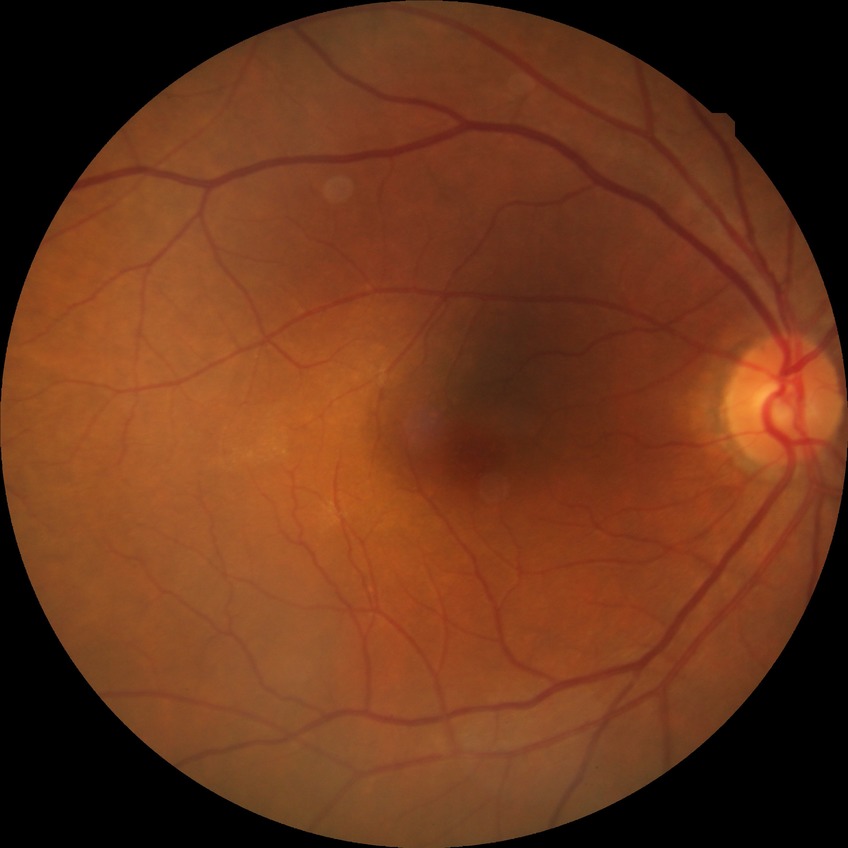 Diabetic retinopathy (DR): no diabetic retinopathy (NDR).